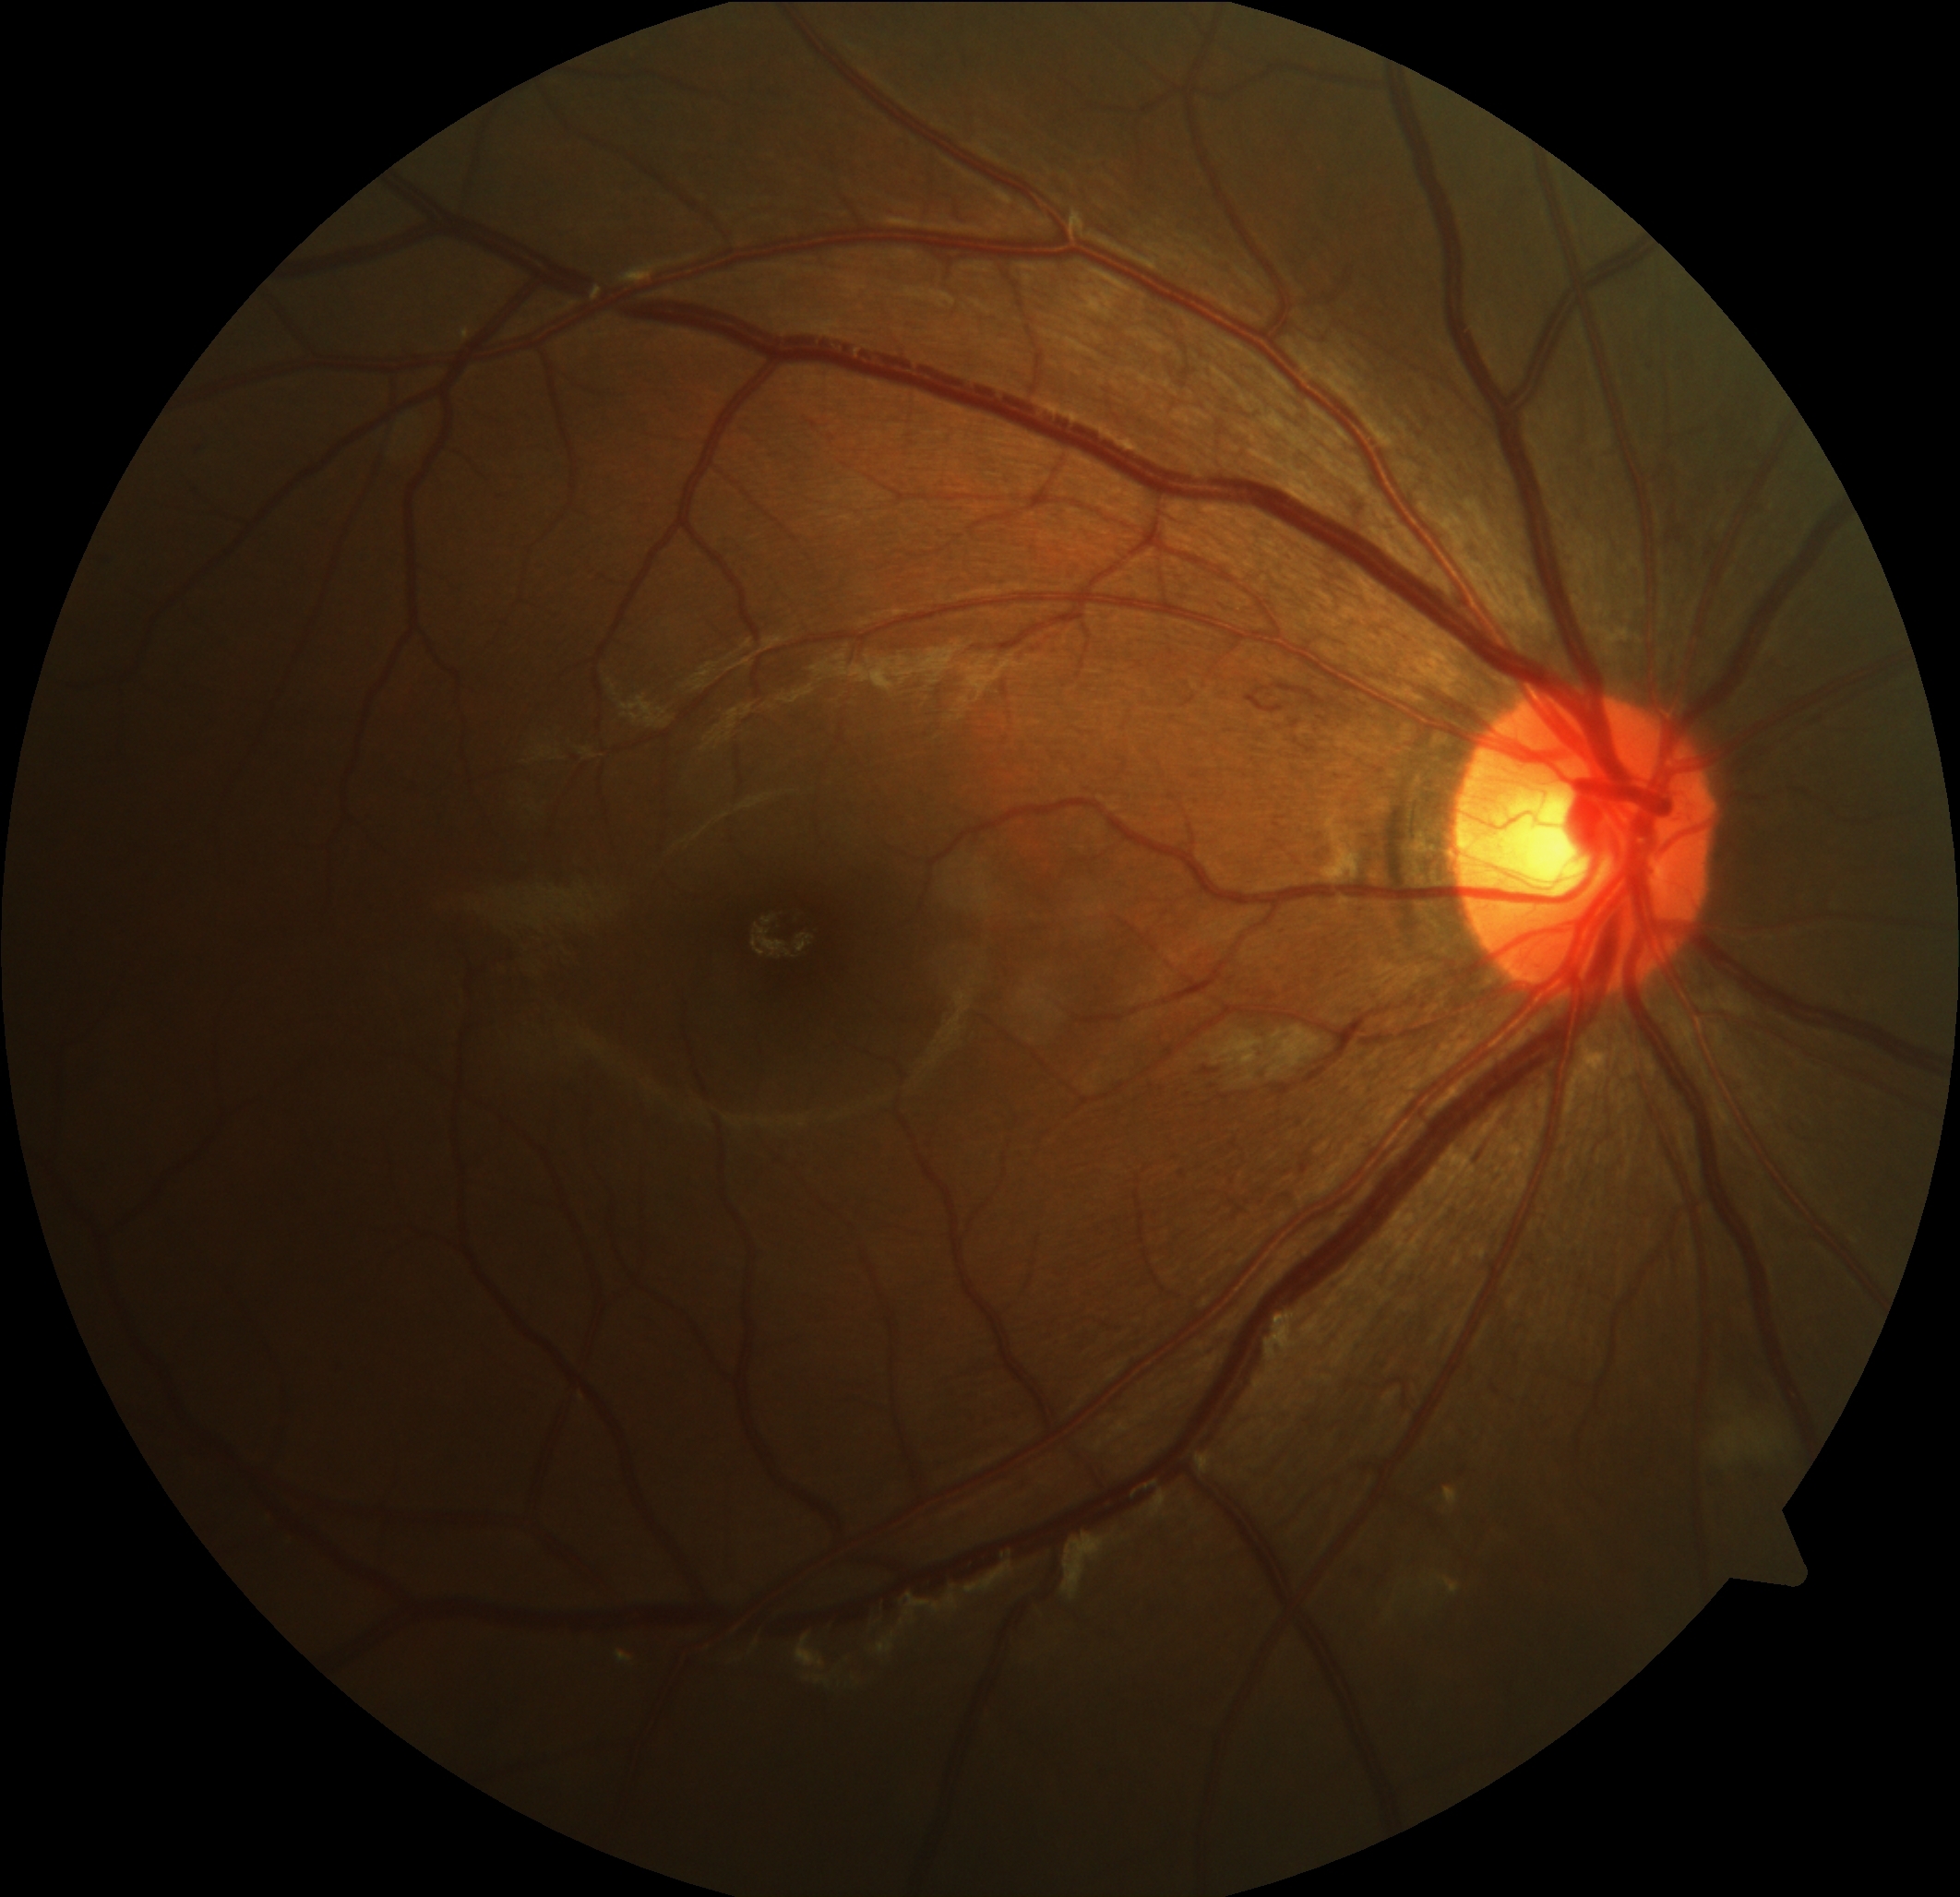
dr_grade: grade 2 (moderate NPDR)